Nonmydriatic fundus photograph. 848 by 848 pixels. NIDEK AFC-230 fundus camera. Fundus photo. FOV: 45 degrees.
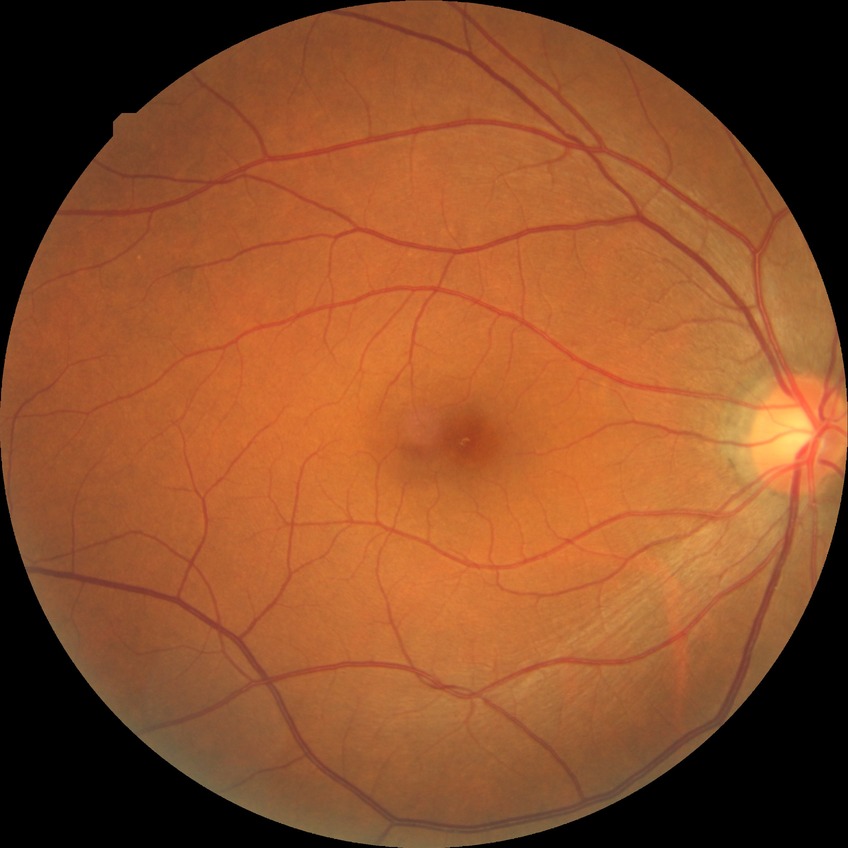
{
  "davis_grade": "NDR"
}